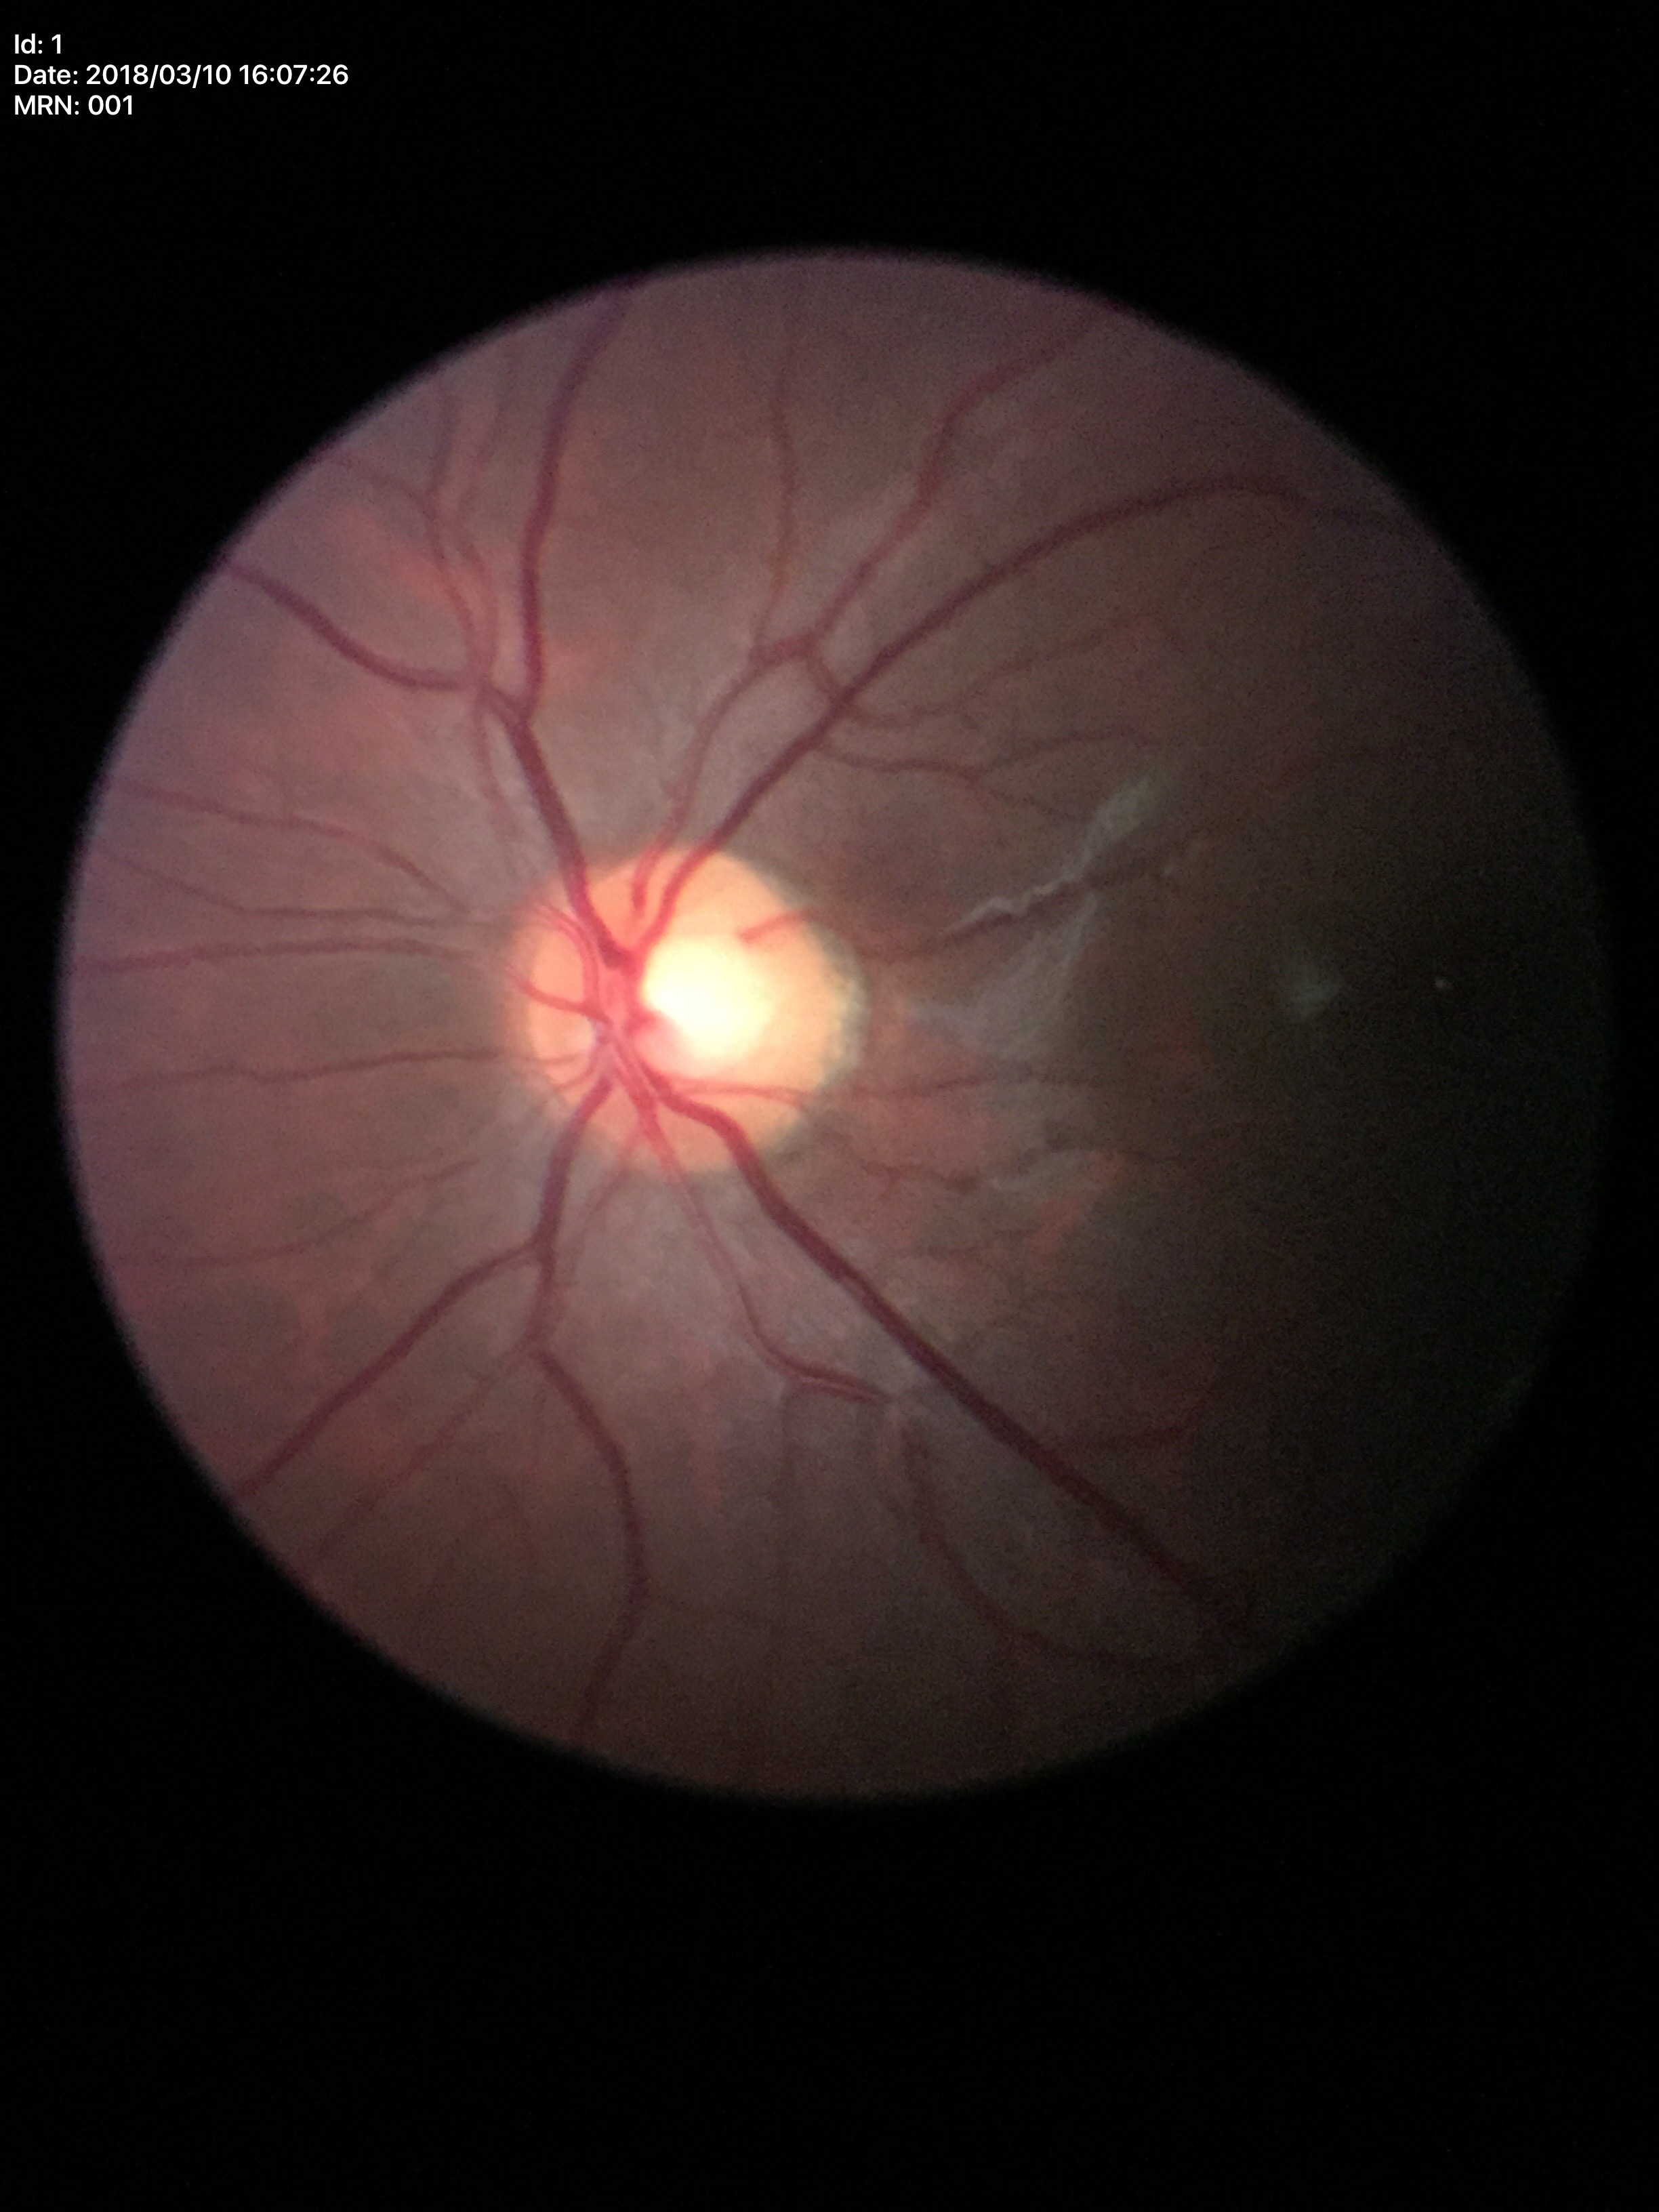 Not suspicious for glaucoma. VCDR: 0.54.